848x848 · NIDEK AFC-230 fundus camera:
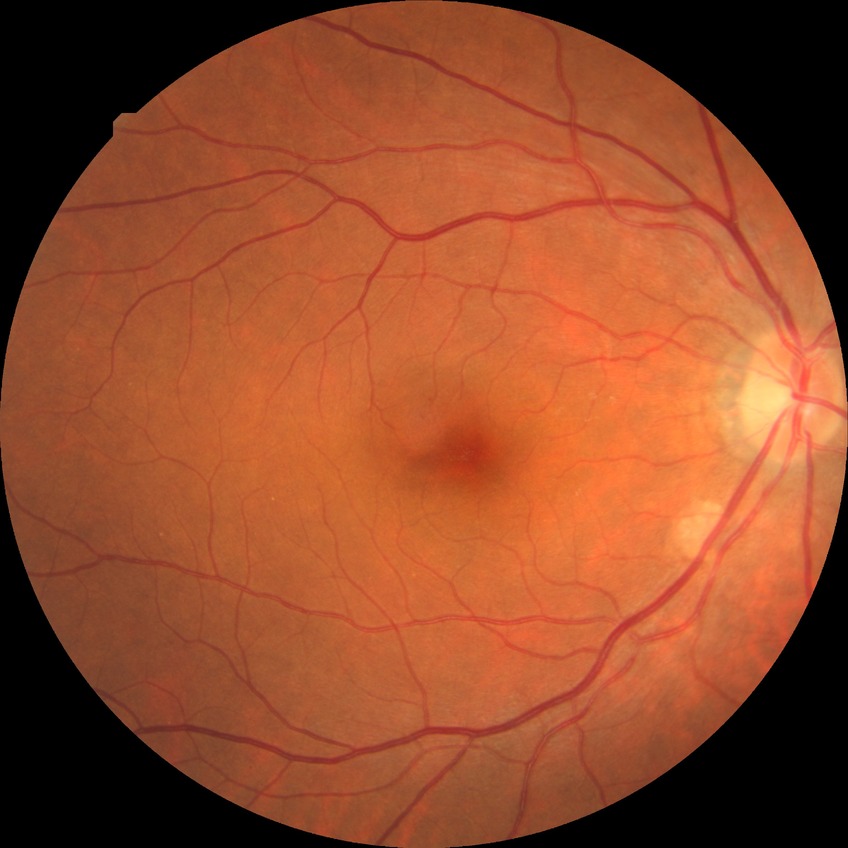 Diabetic retinopathy (DR) is no diabetic retinopathy (NDR).